CFP.
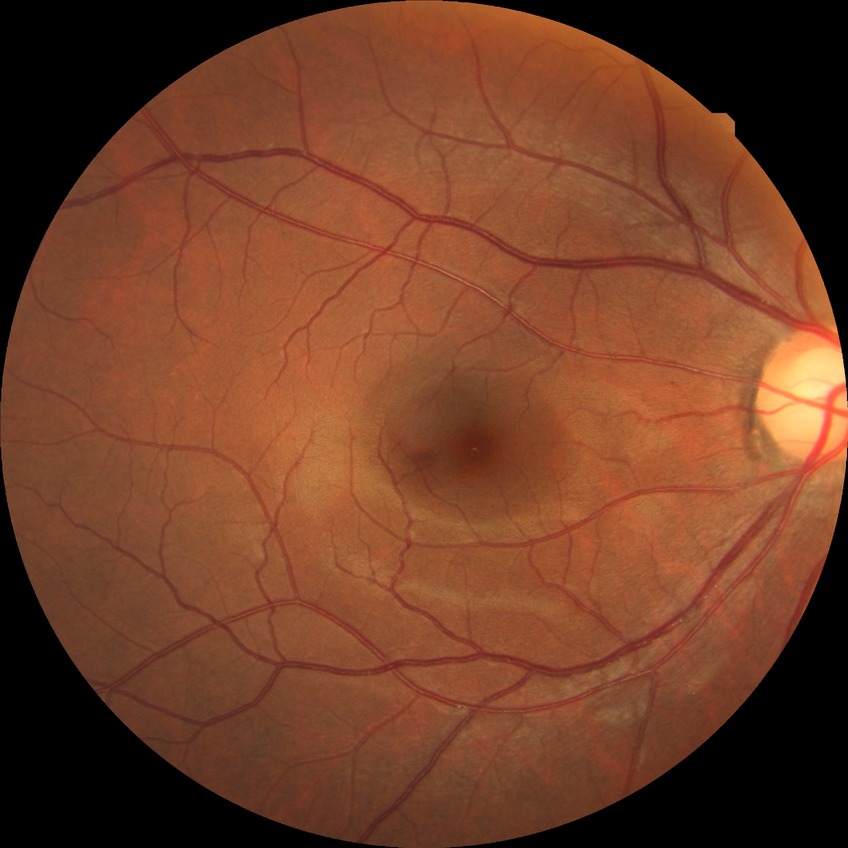

Retinopathy stage: no diabetic retinopathy.